Captured on a Nidek AFC-330 fundus camera · 240 x 240 pixels — 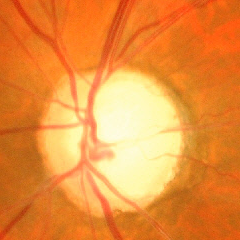

Findings consistent with glaucoma. Color fundus photograph showing advanced glaucomatous optic neuropathy.